Infant wide-field fundus photograph: 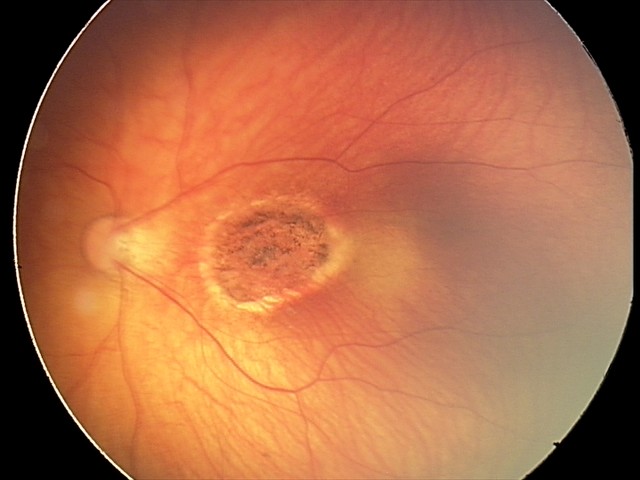
Screening examination consistent with toxoplasmosis chorioretinitis.